1440x1080. 130° field of view (Natus RetCam Envision). Pediatric retinal photograph (wide-field) — 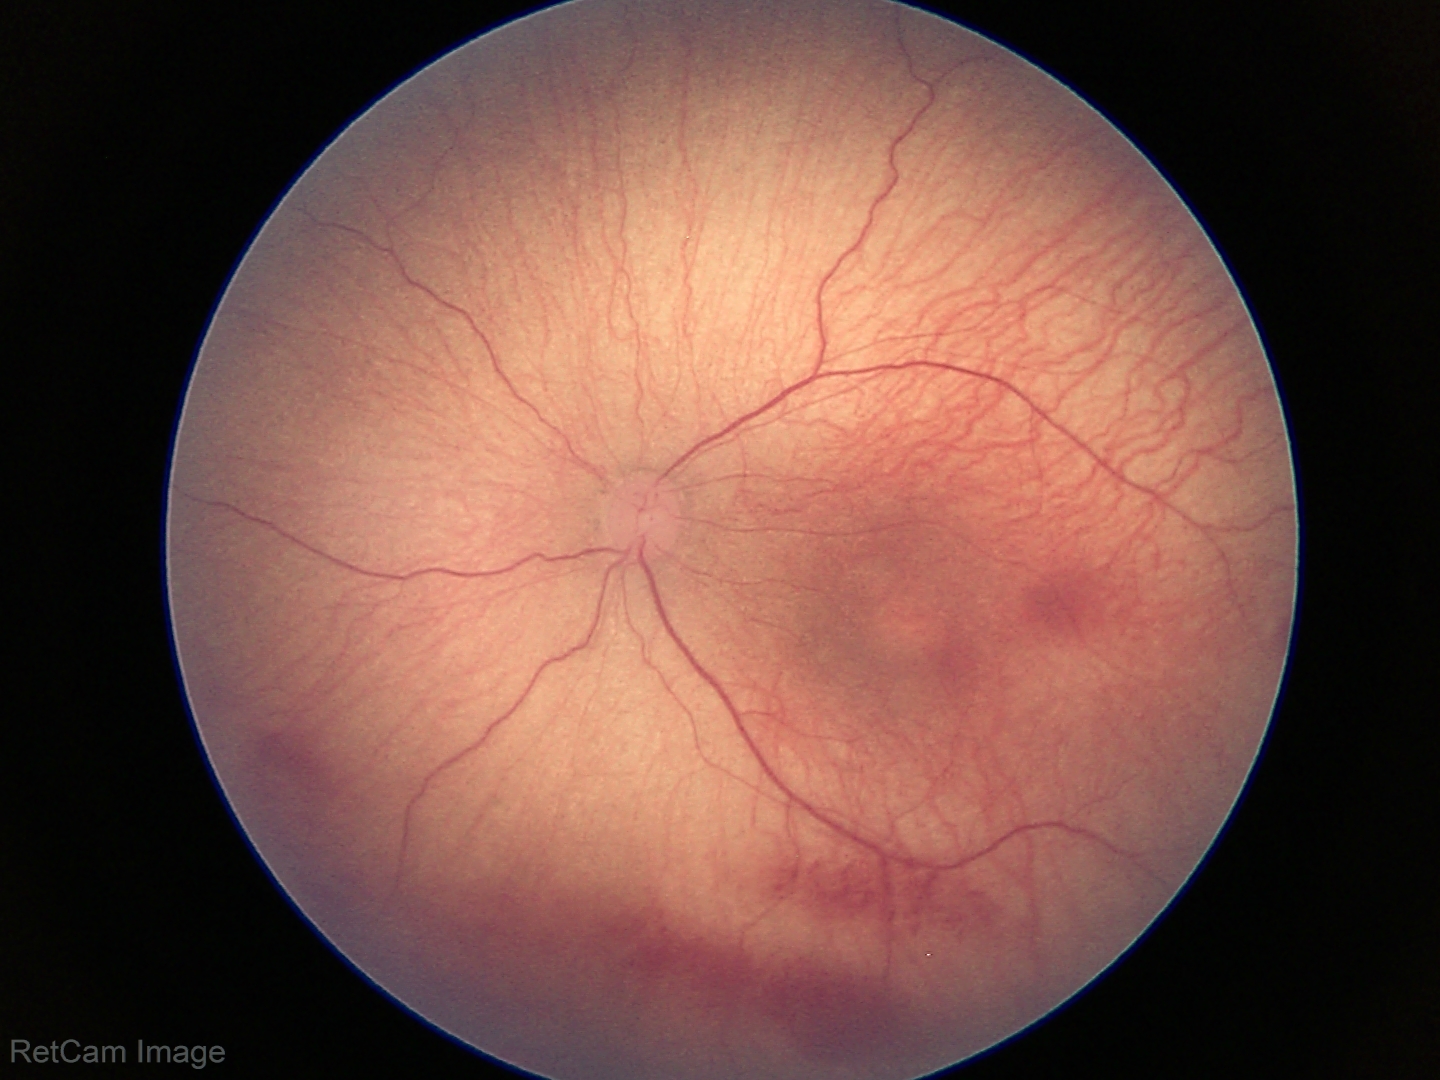
Without plus disease. Diagnosis from this screening exam: retinopathy of prematurity stage 1.